Retinal fundus photograph; camera: Remidio Fundus on Phone (FOP) camera: 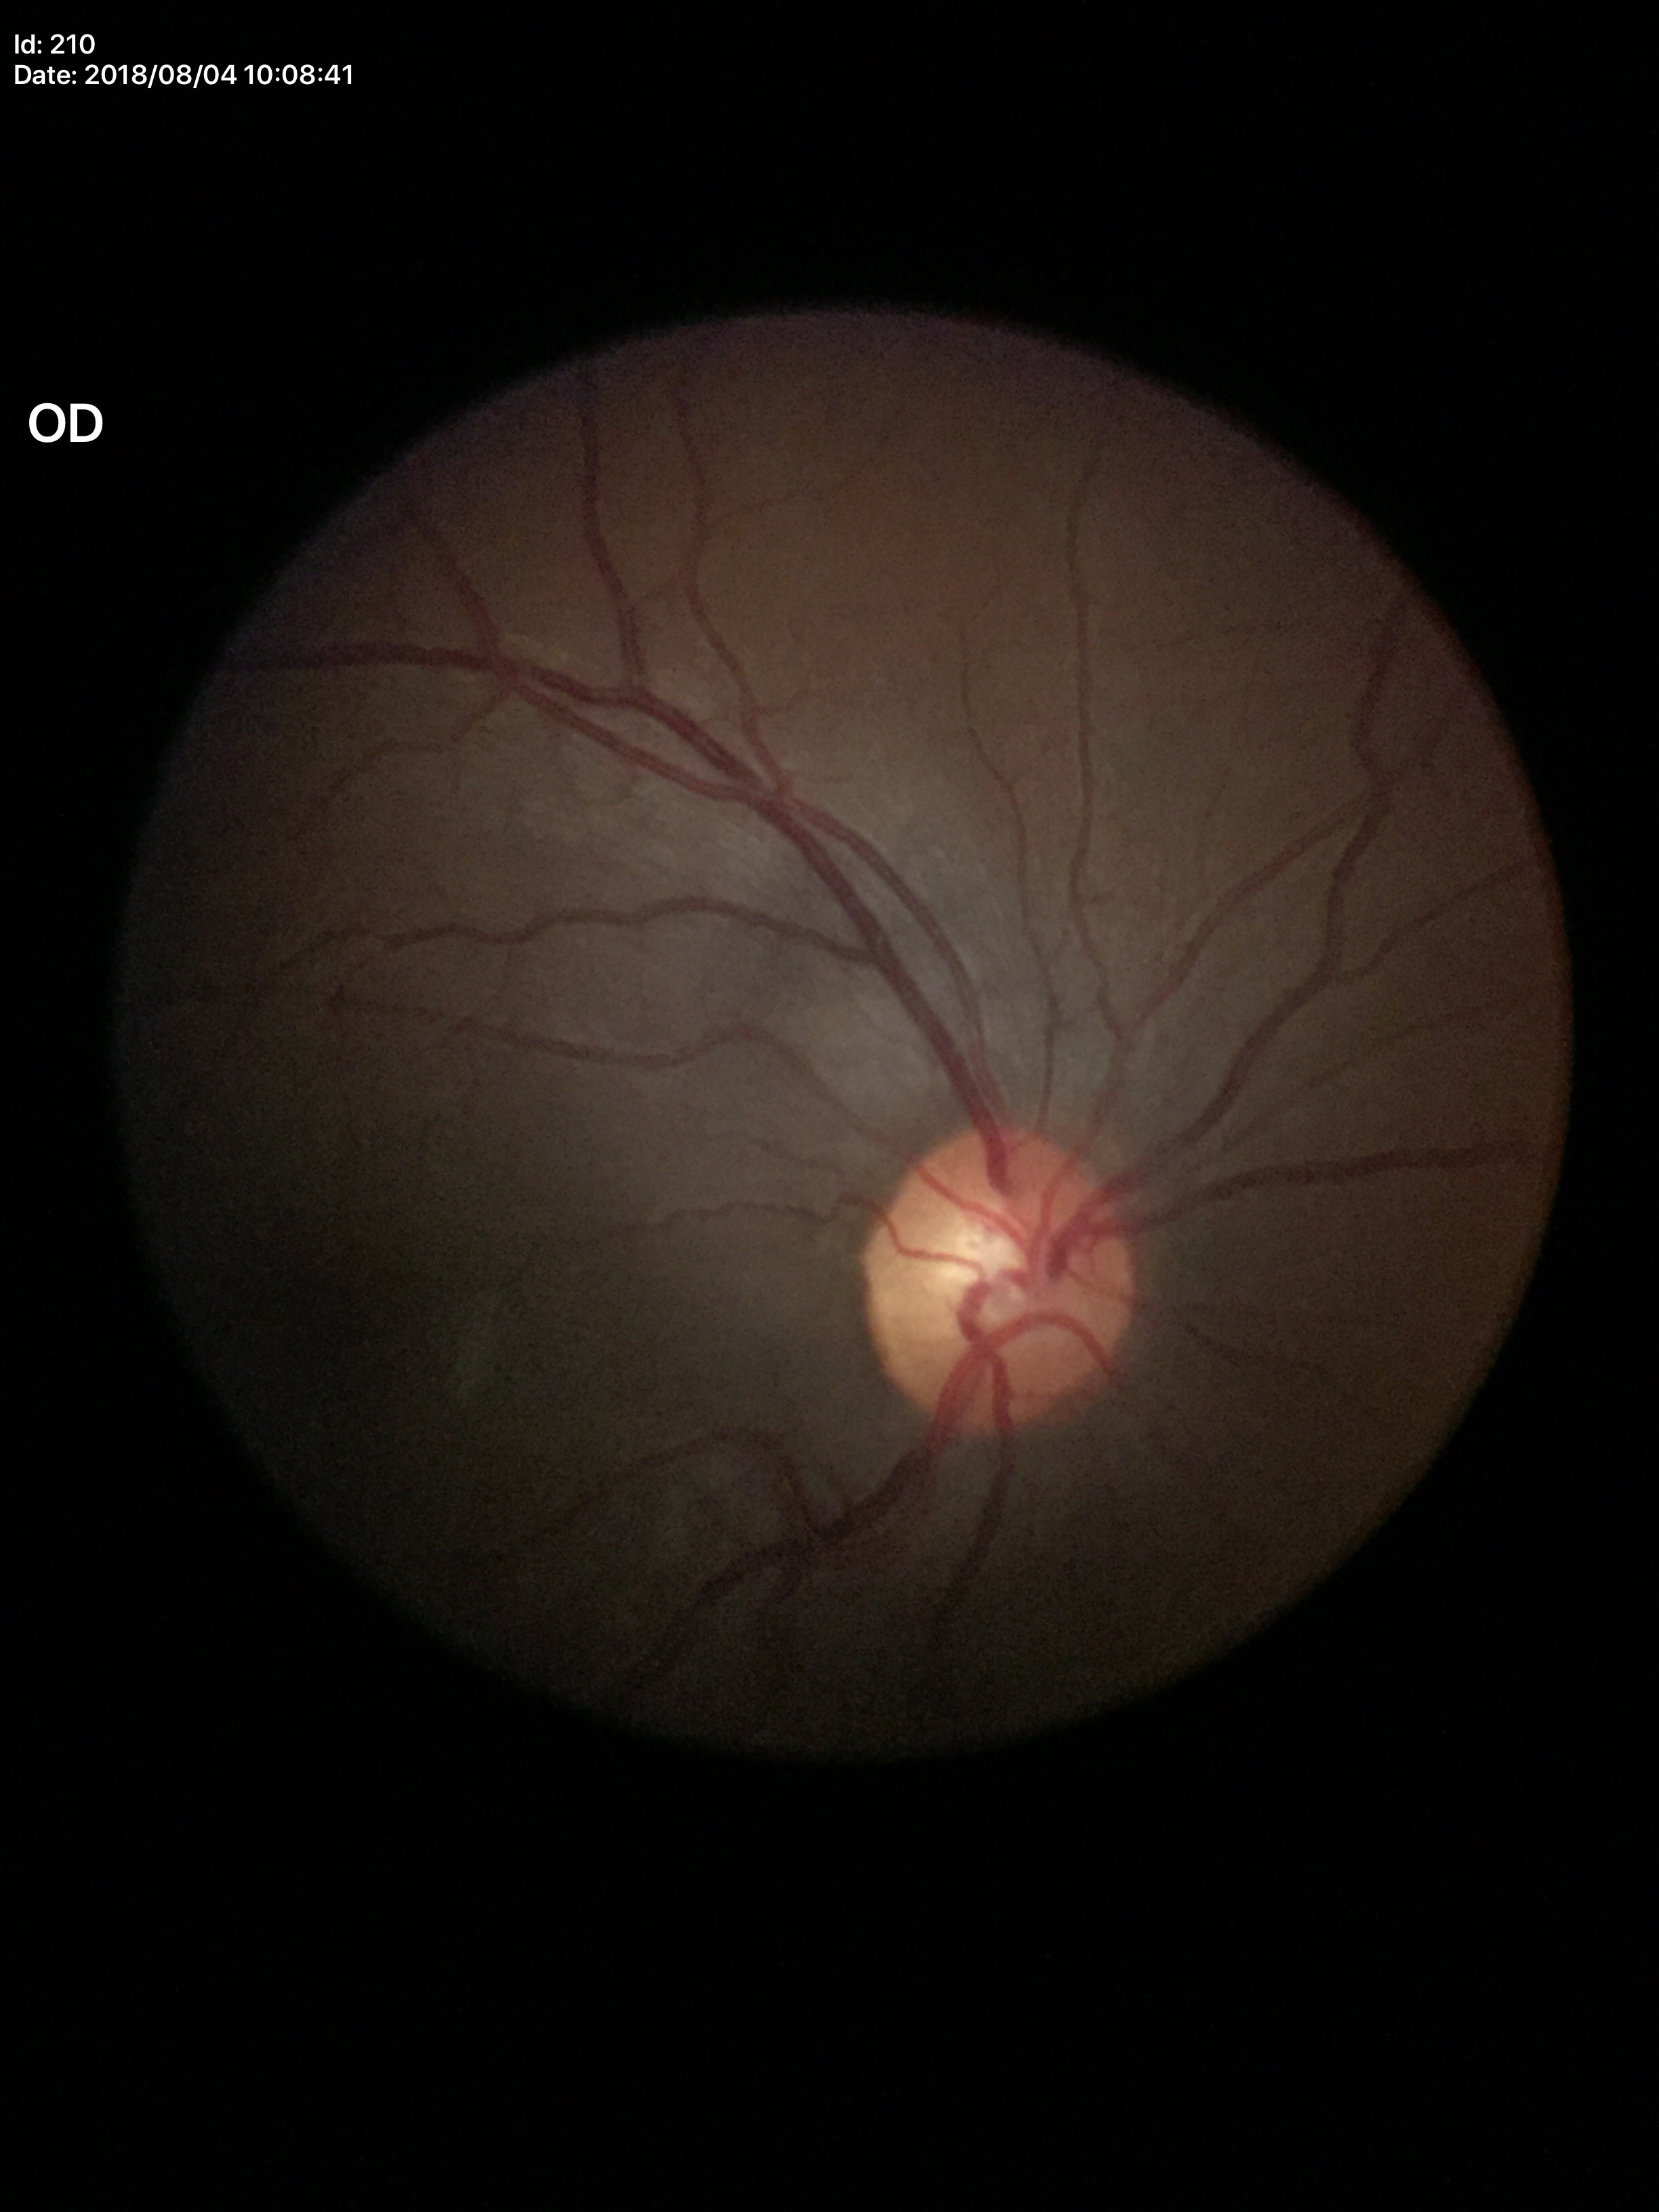
Glaucoma screening: no suspicious findings
vertical cup-to-disc ratio: 0.49